30° FOV · retinal fundus photograph — 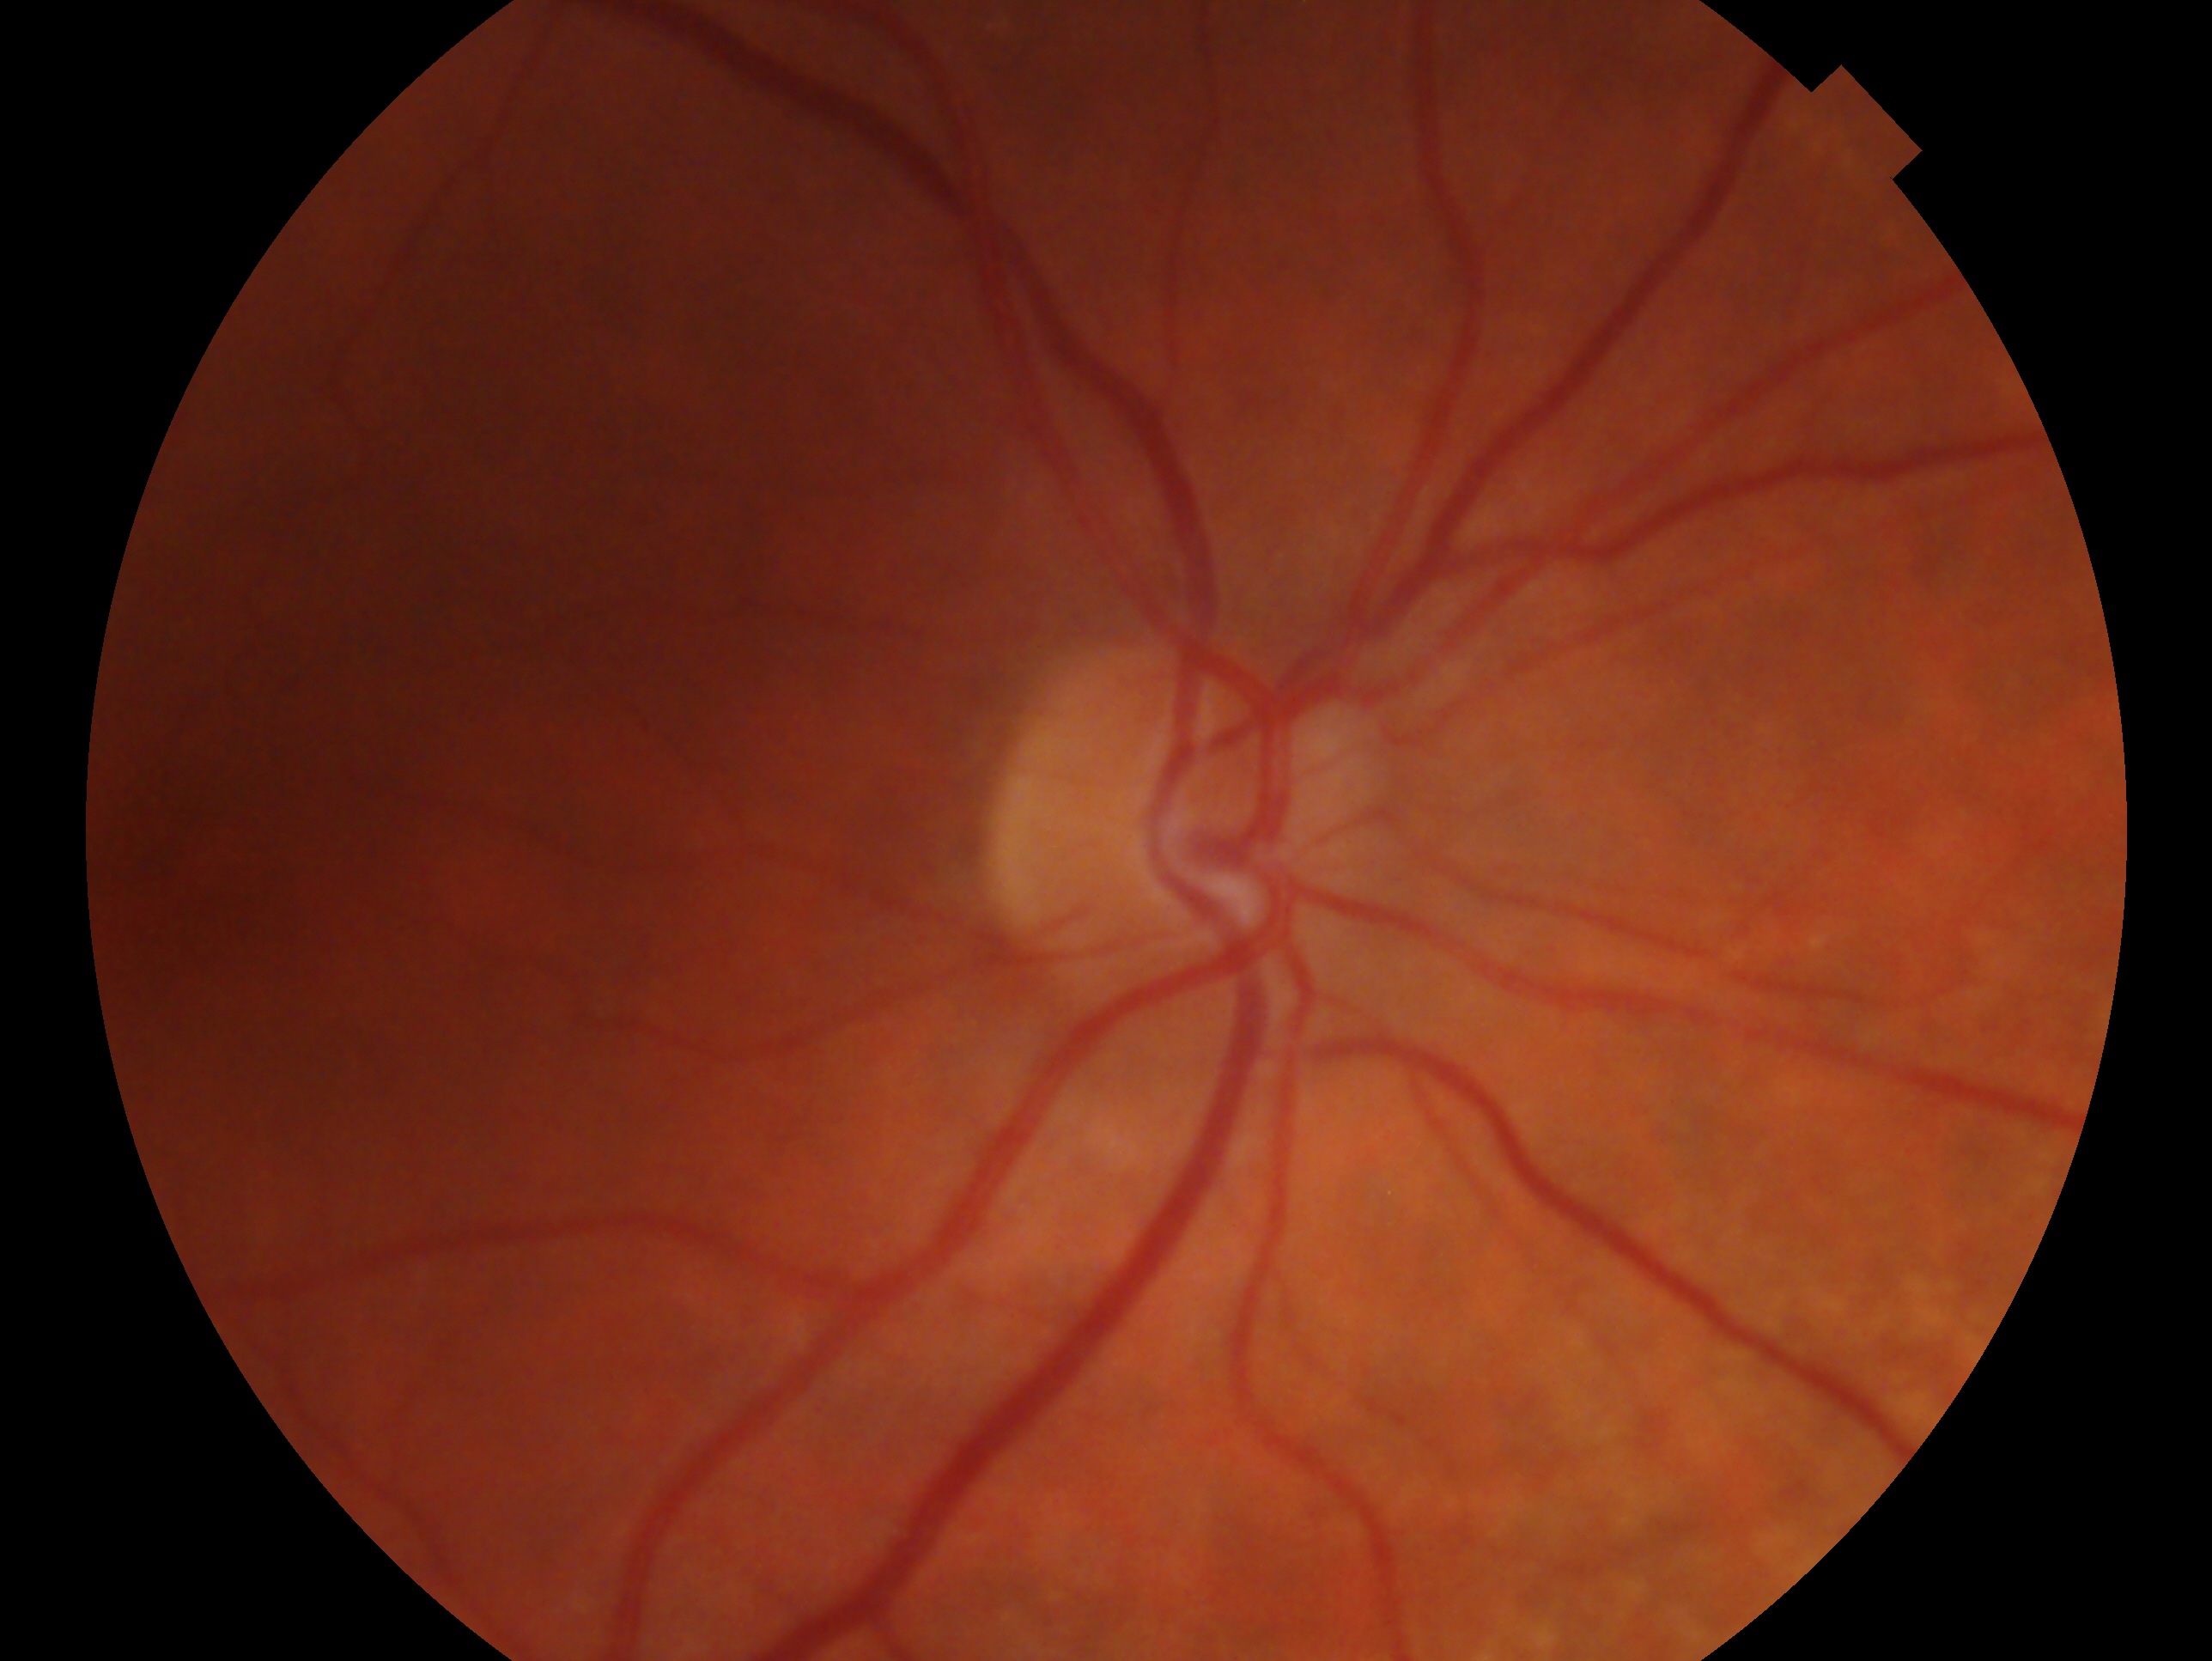

Assessment — no signs of glaucoma. Imaged eye: oculus dexter.